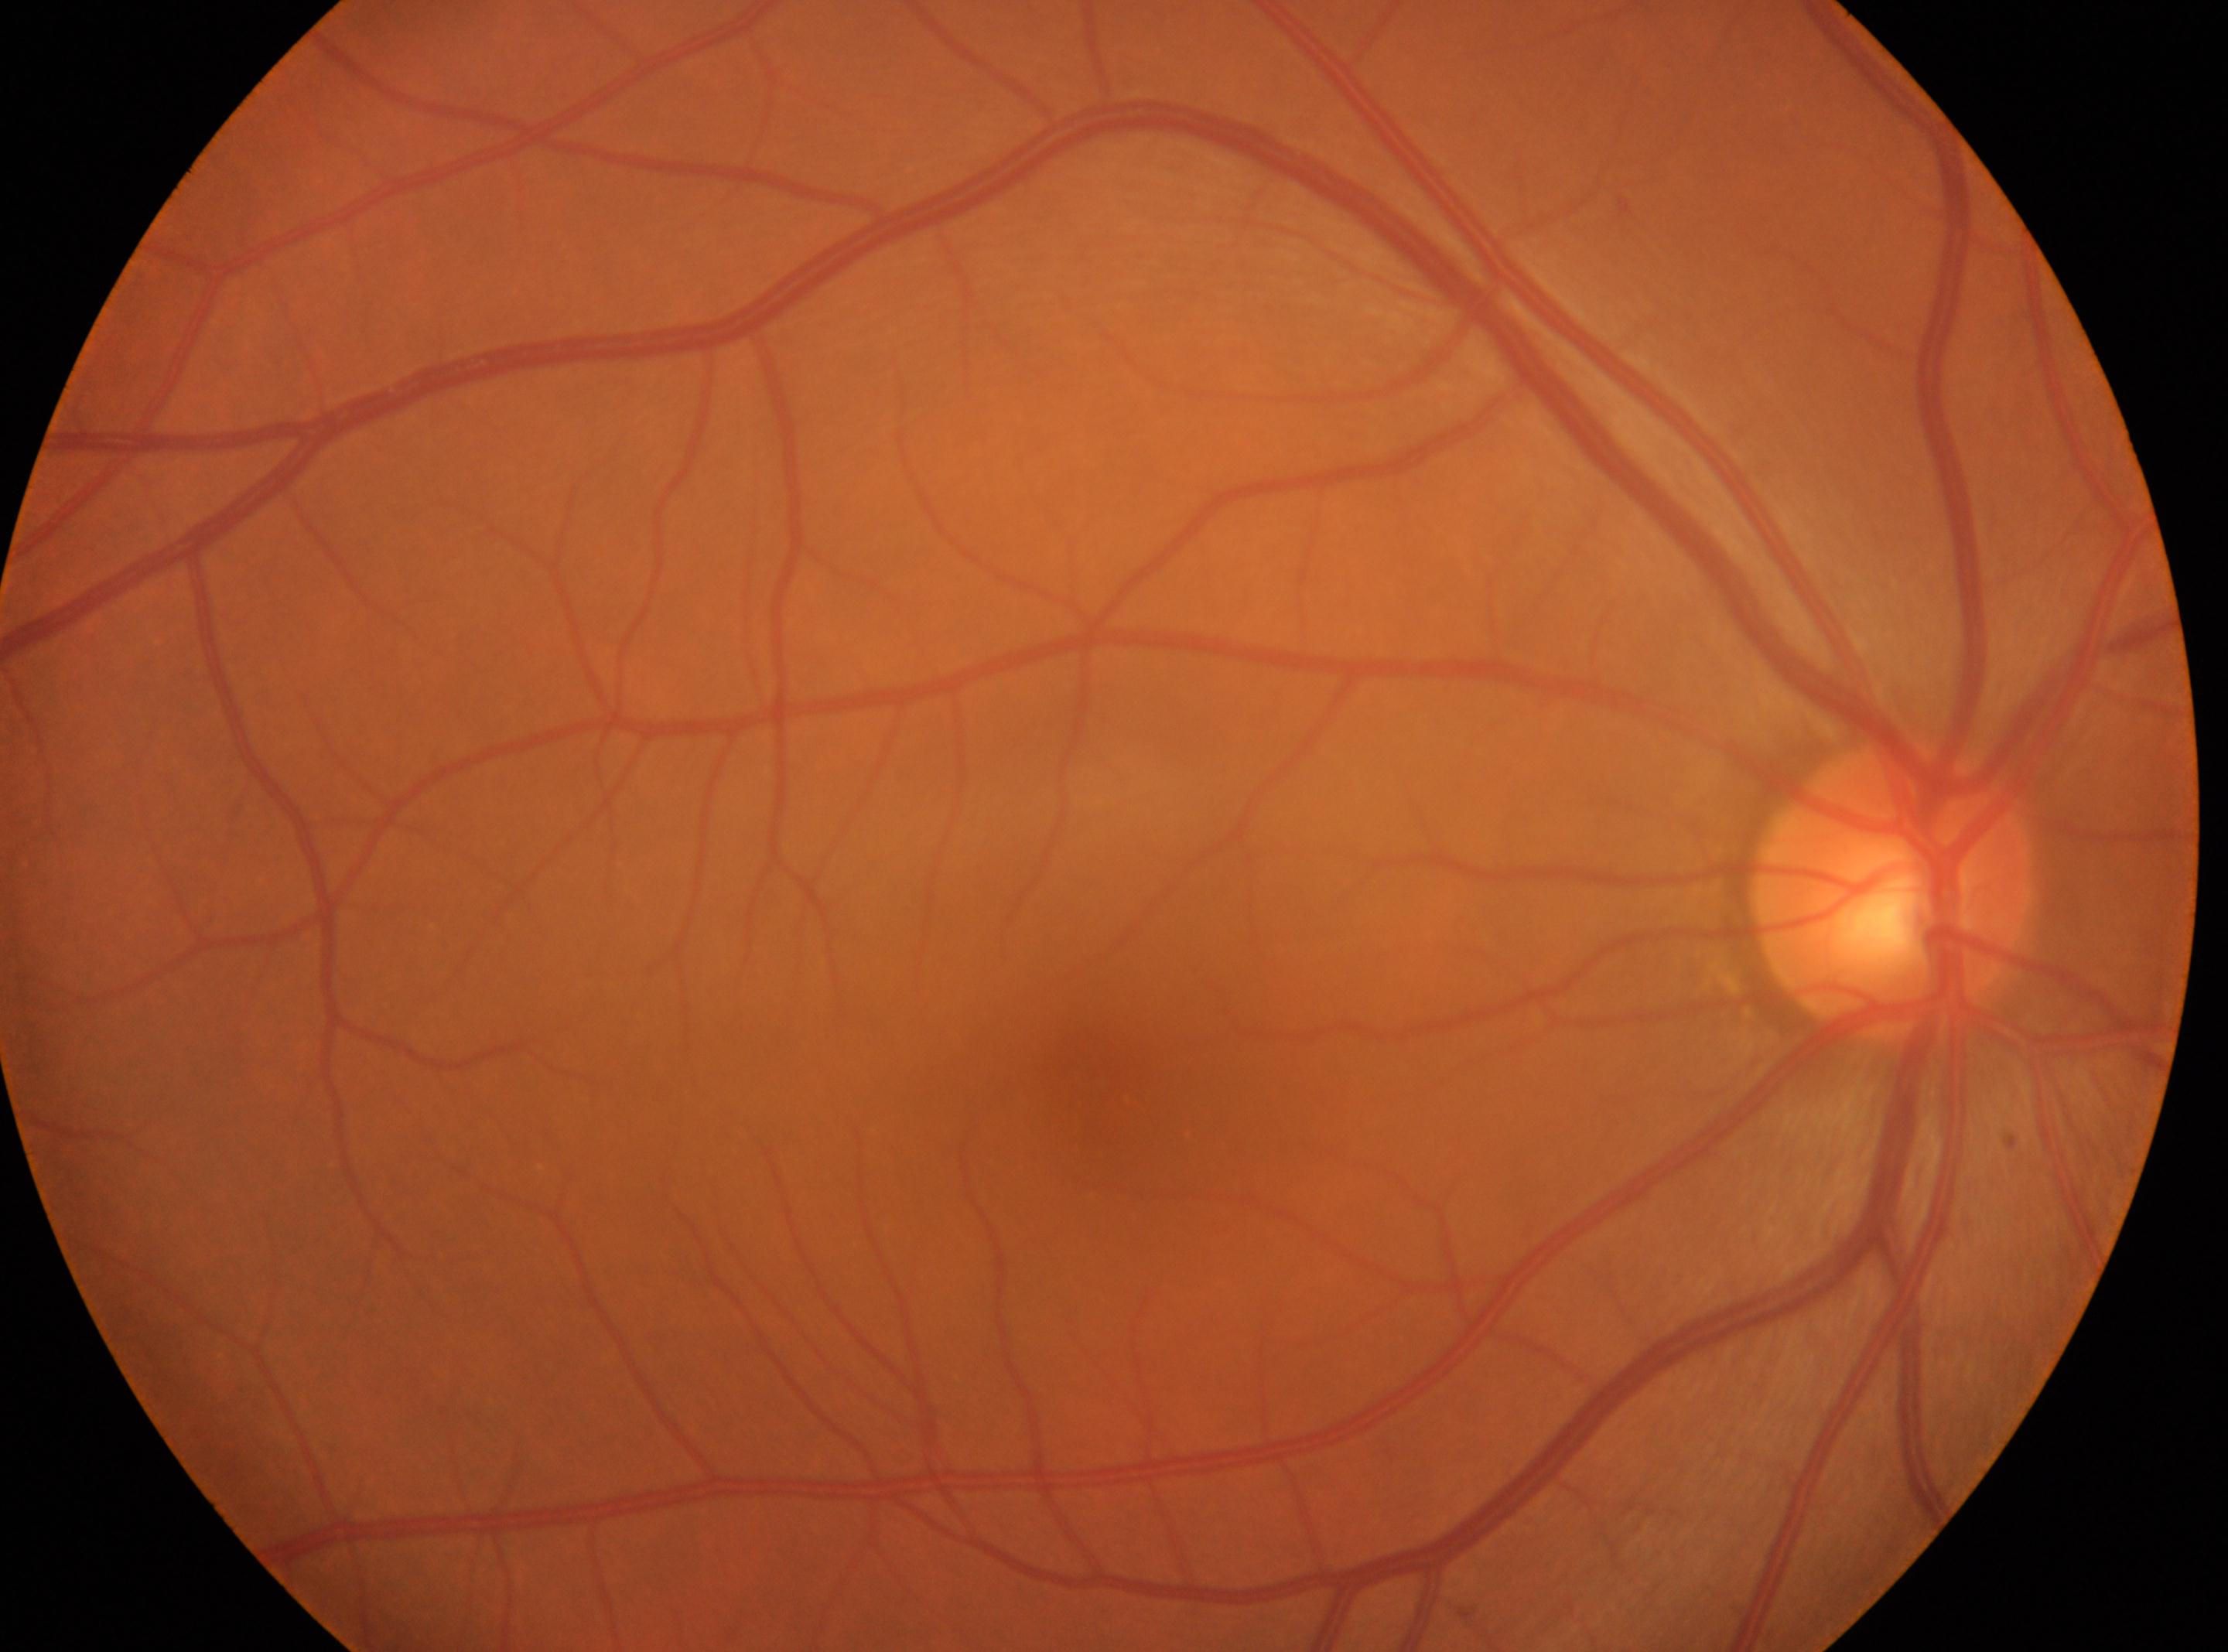
Findings:
• the optic disc: (x: 1895, y: 889)
• laterality: the right eye
• macula center: (x: 1103, y: 1098)
• DR grade: 0 — no visible signs of diabetic retinopathy